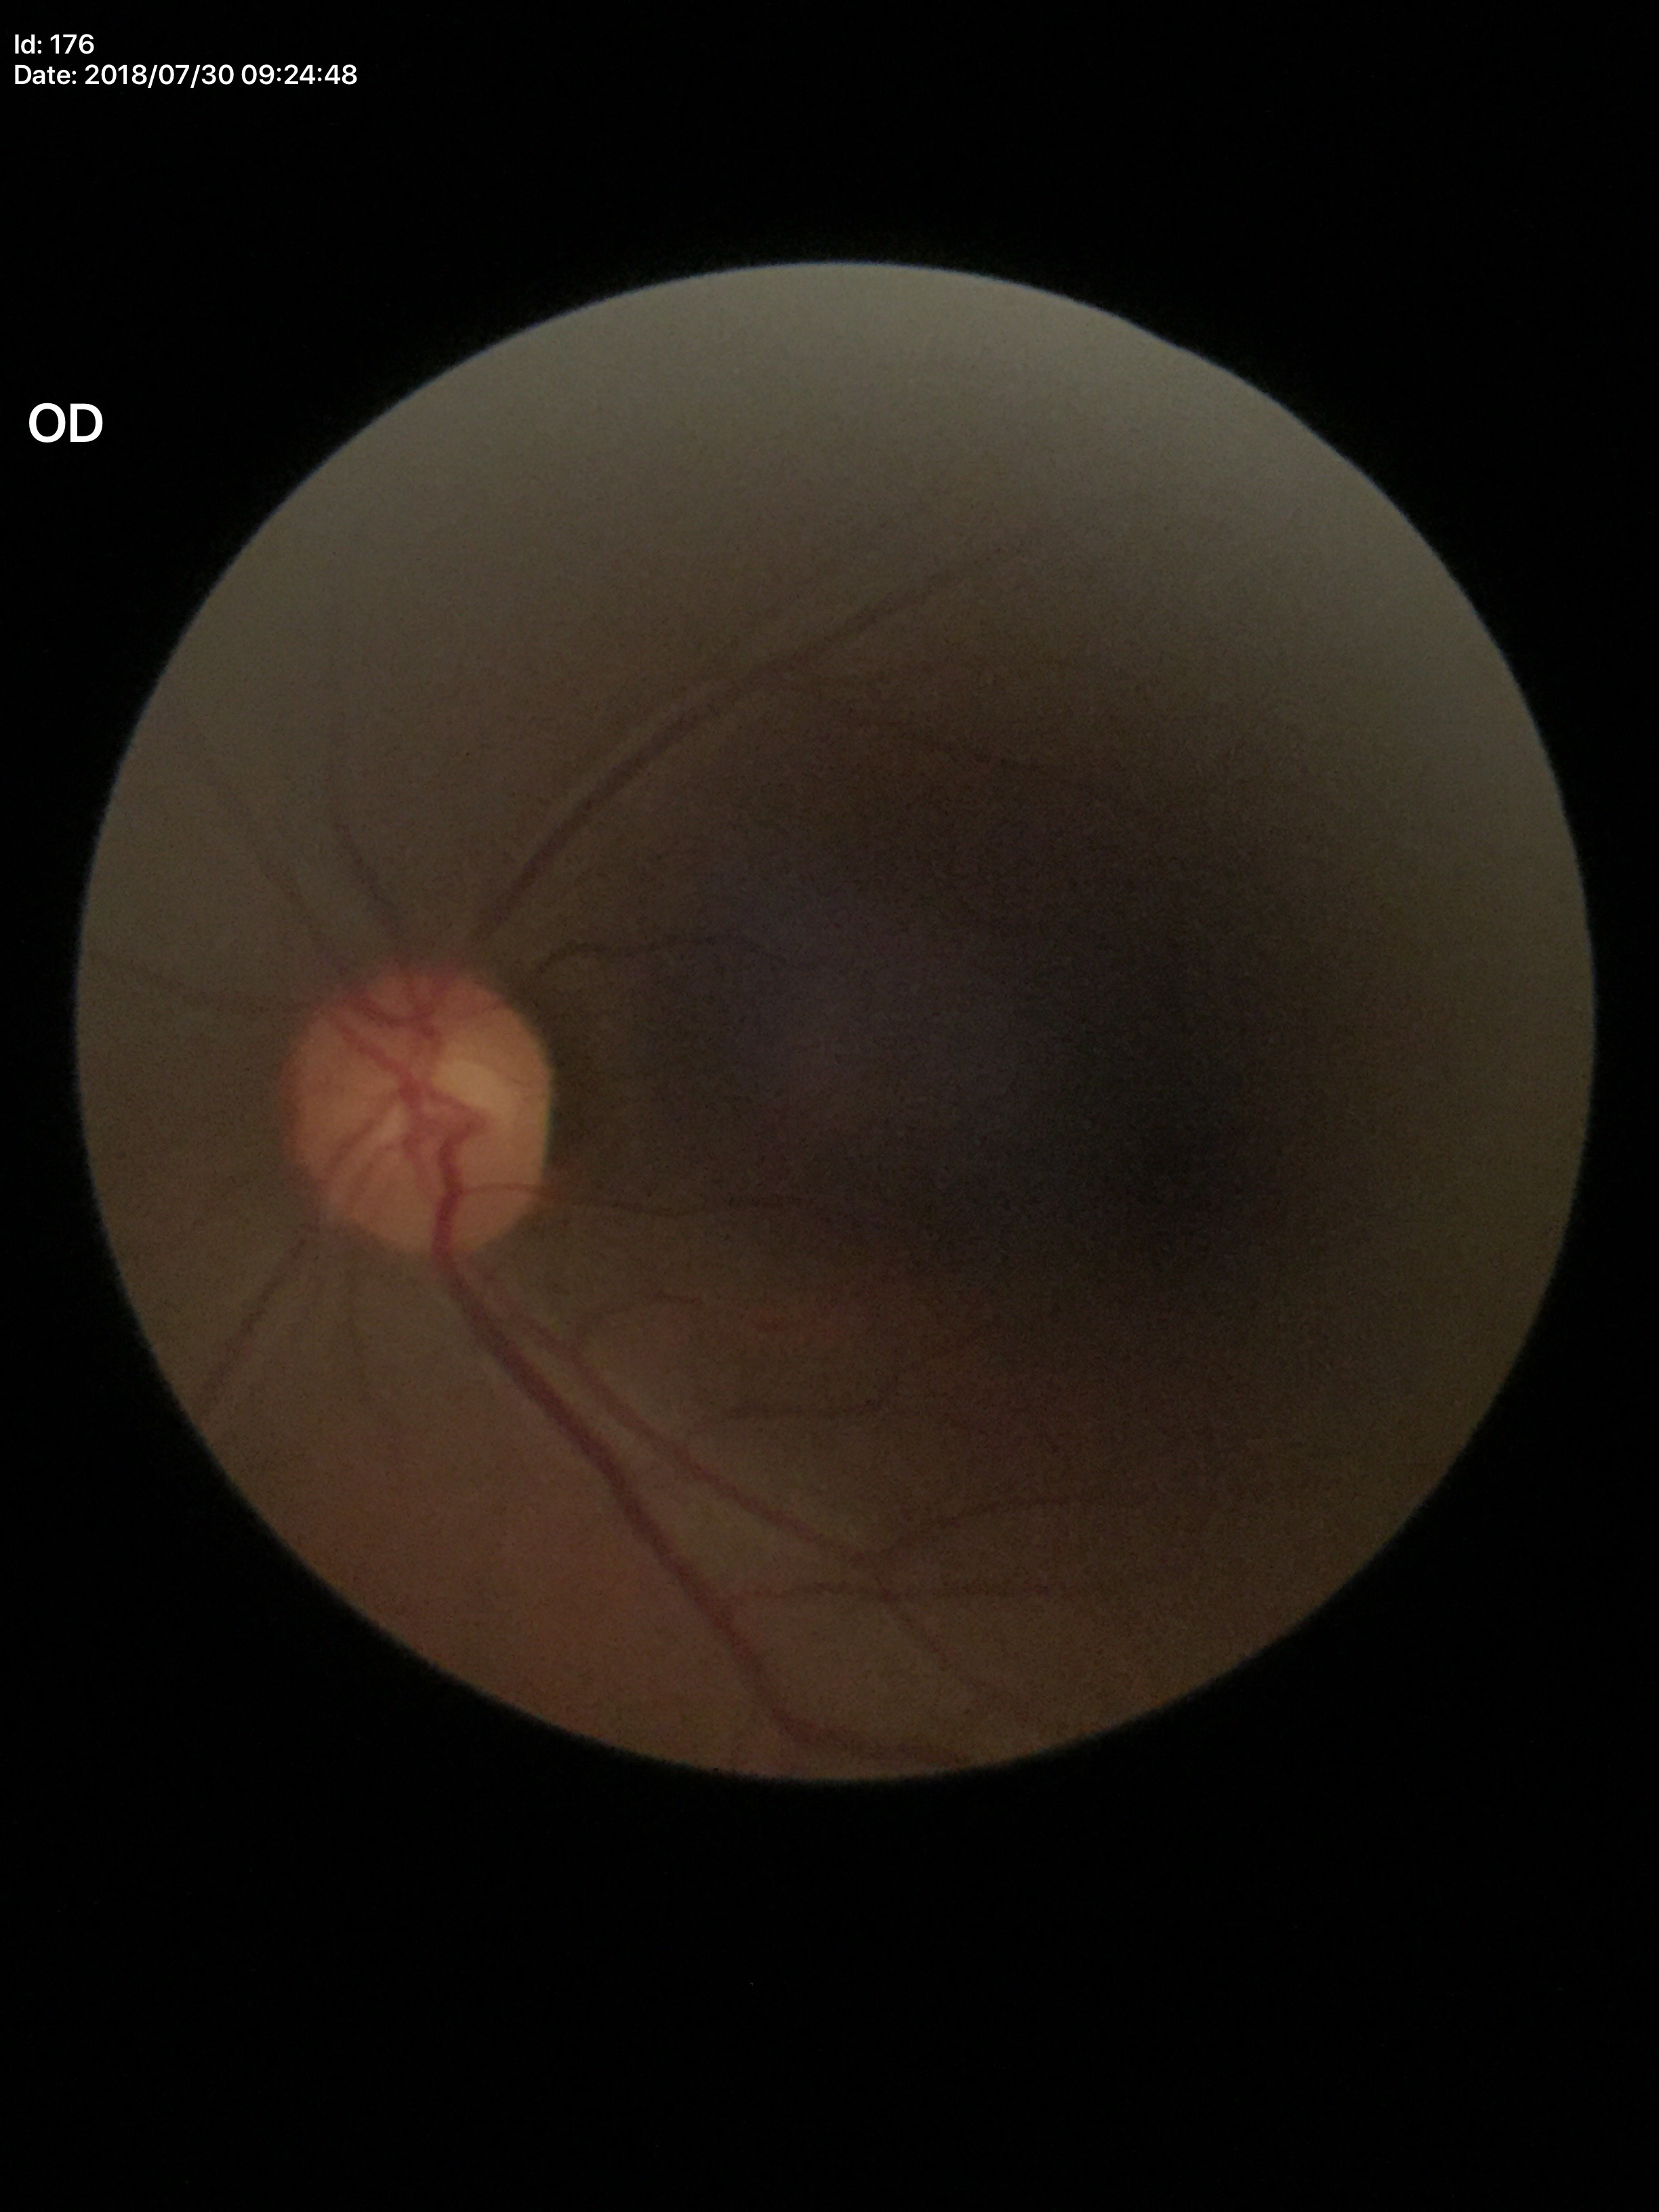 Glaucoma screening impression: negative. Vertical CDR of 0.50. Area CDR: 0.27. Horizontal CDR: 0.55.